Retinal fundus photograph. Acquired with a Remidio smartphone fundus camera — 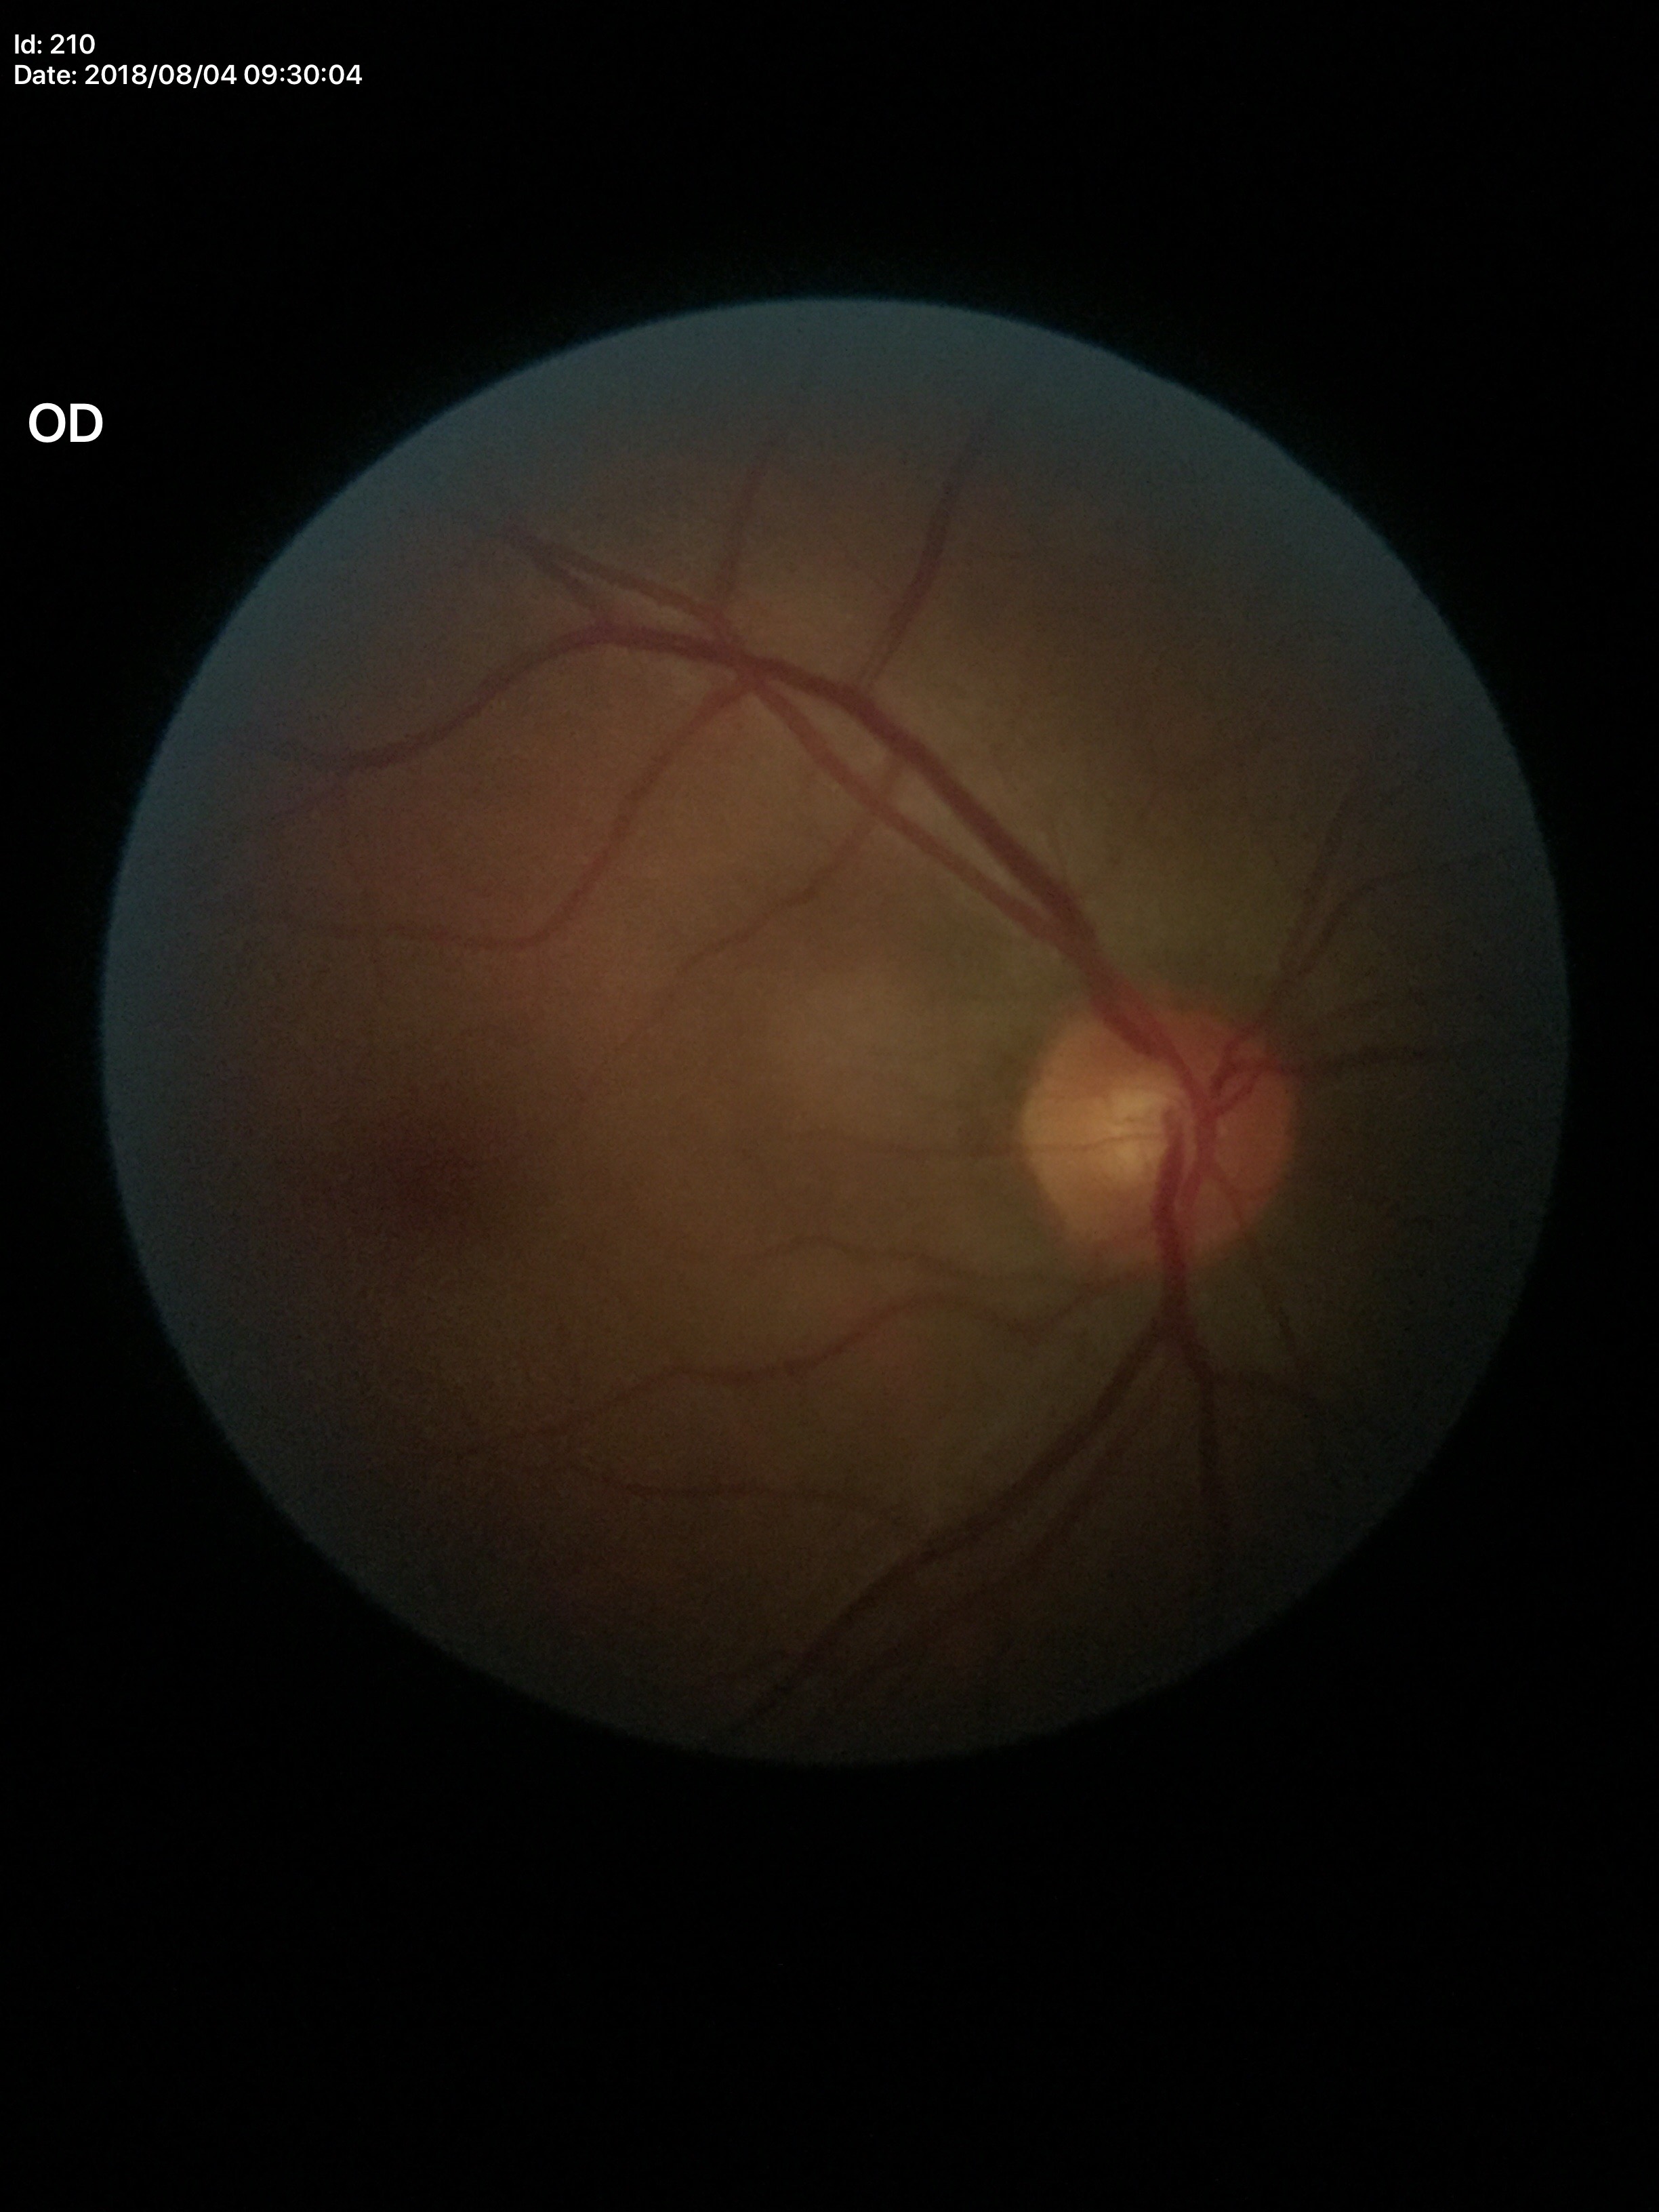 Horizontal cup-disc ratio of 0.52. Vertical cup-to-disc ratio is 0.55. Glaucoma impression: no suspicious findings.